Infant wide-field retinal image — 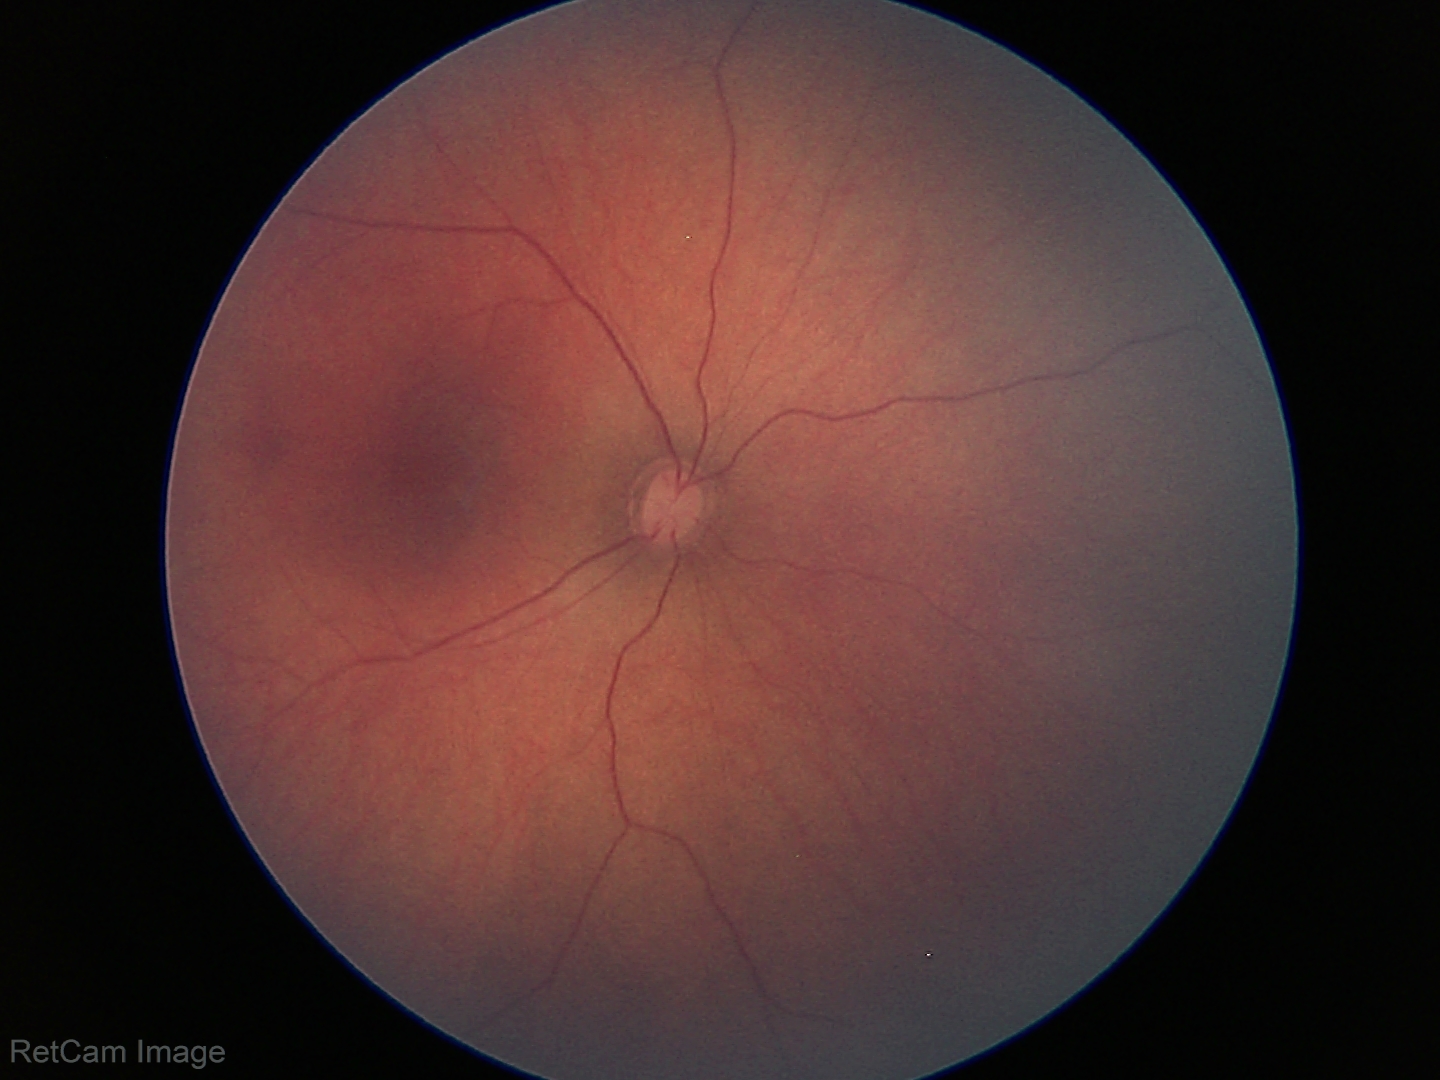

Examination with physiological retinal findings.